Retinal fundus photograph. Image size 2352x1568
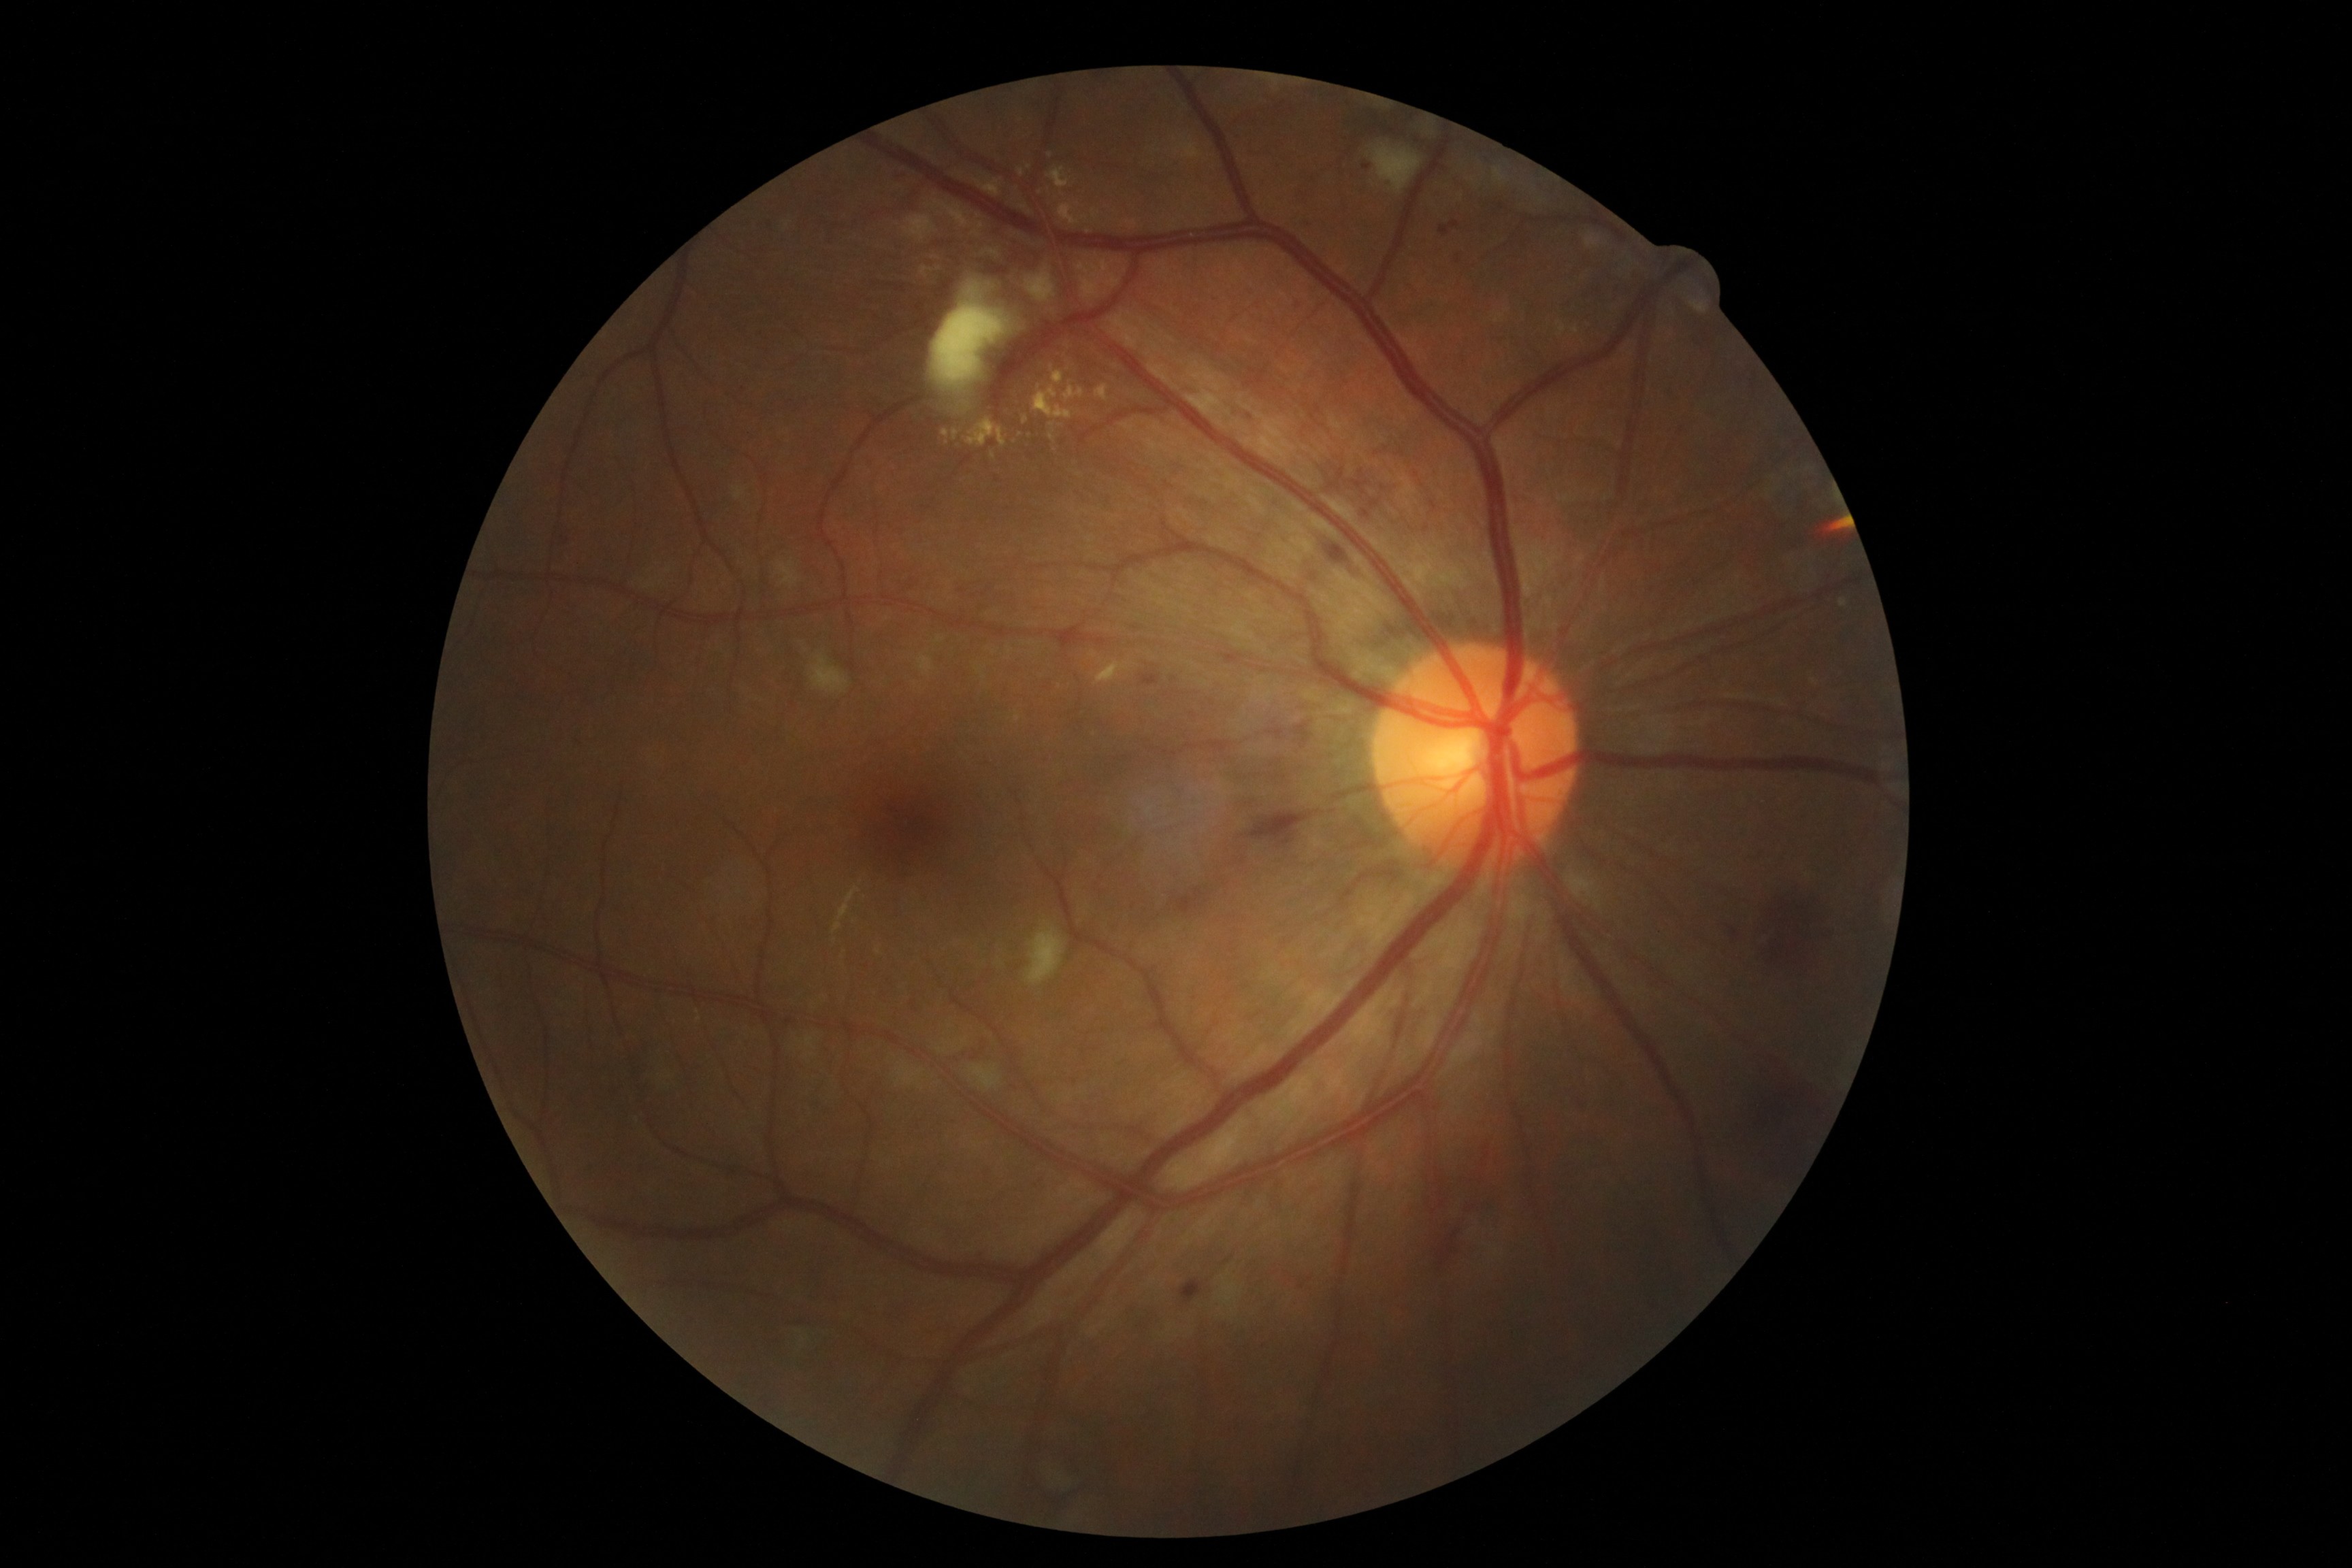

DR grade=2.